Retinal fundus photograph:
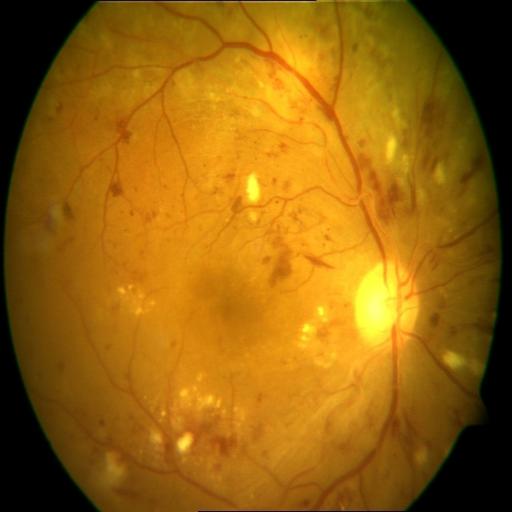
The image shows hemorrhagic retinopathy (HR), cotton wool spots (CWS) & exudation (EDN).